240x240. Nidek AFC-330 — 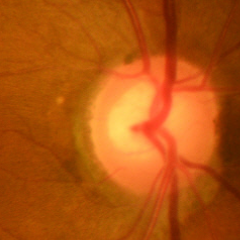 Optic nerve head appearance consistent with no glaucomatous changes.